1536x1152.
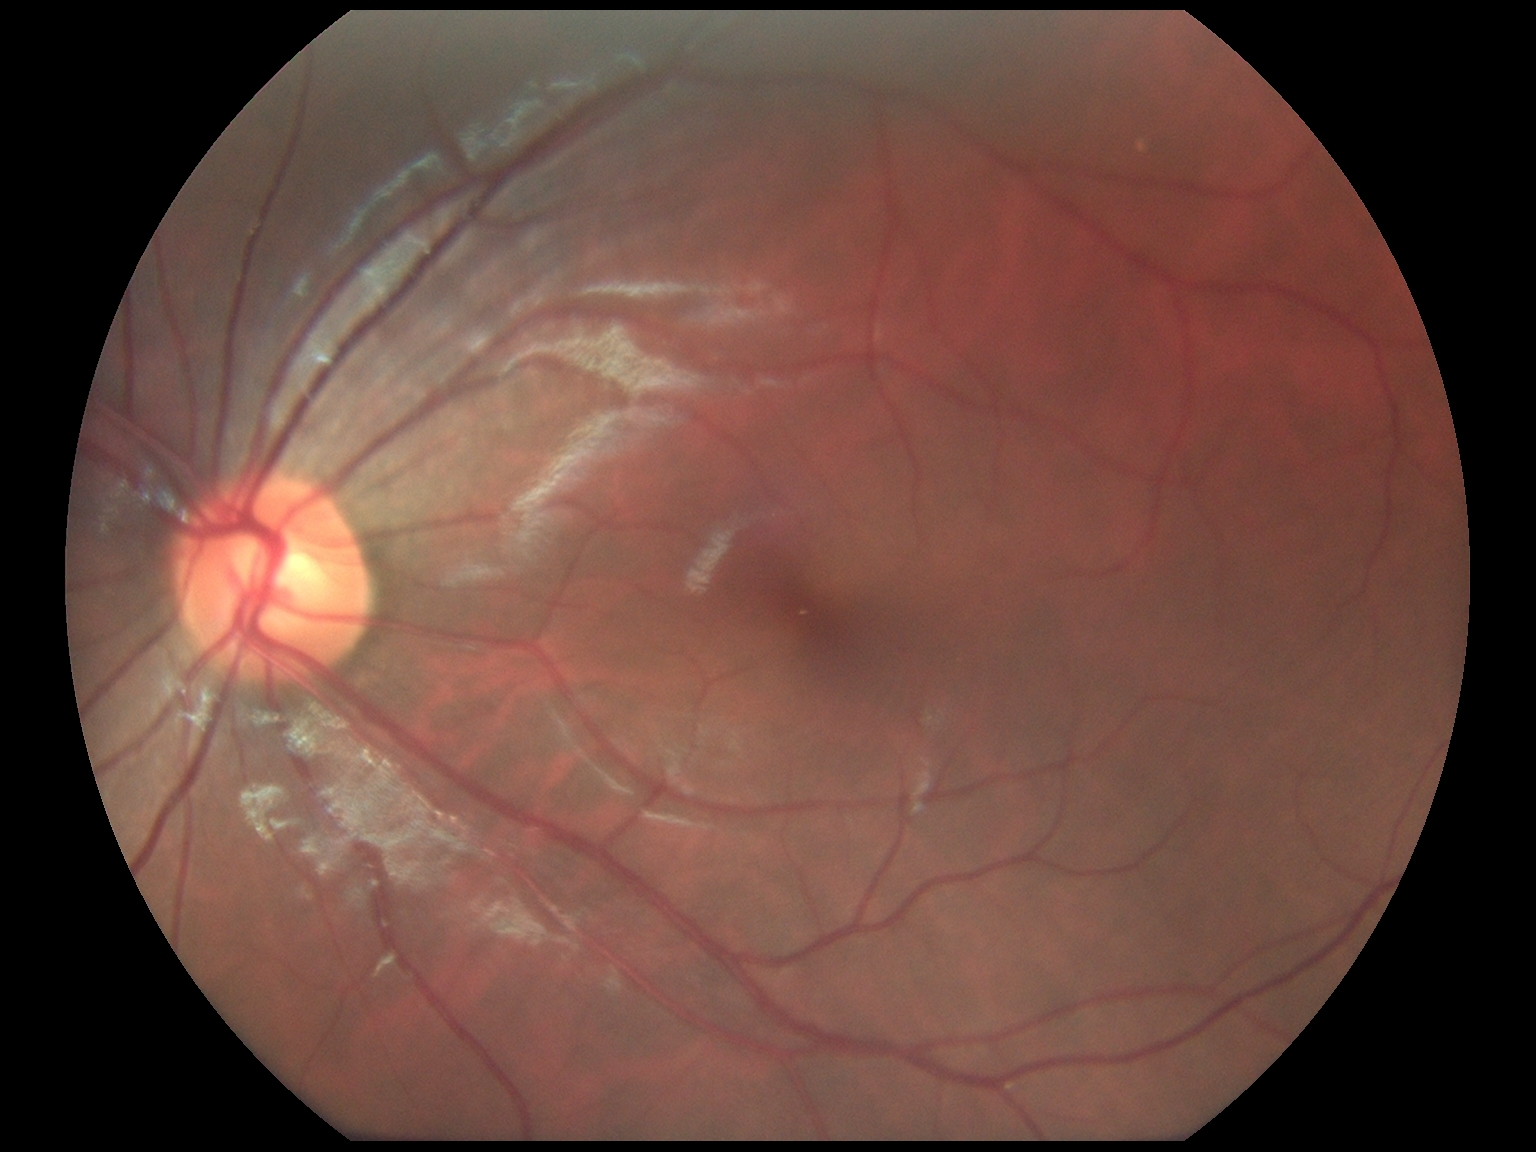 Diabetic retinopathy severity: no apparent retinopathy (grade 0) — no visible signs of diabetic retinopathy. No diabetic retinal disease findings.